Infant wide-field fundus photograph.
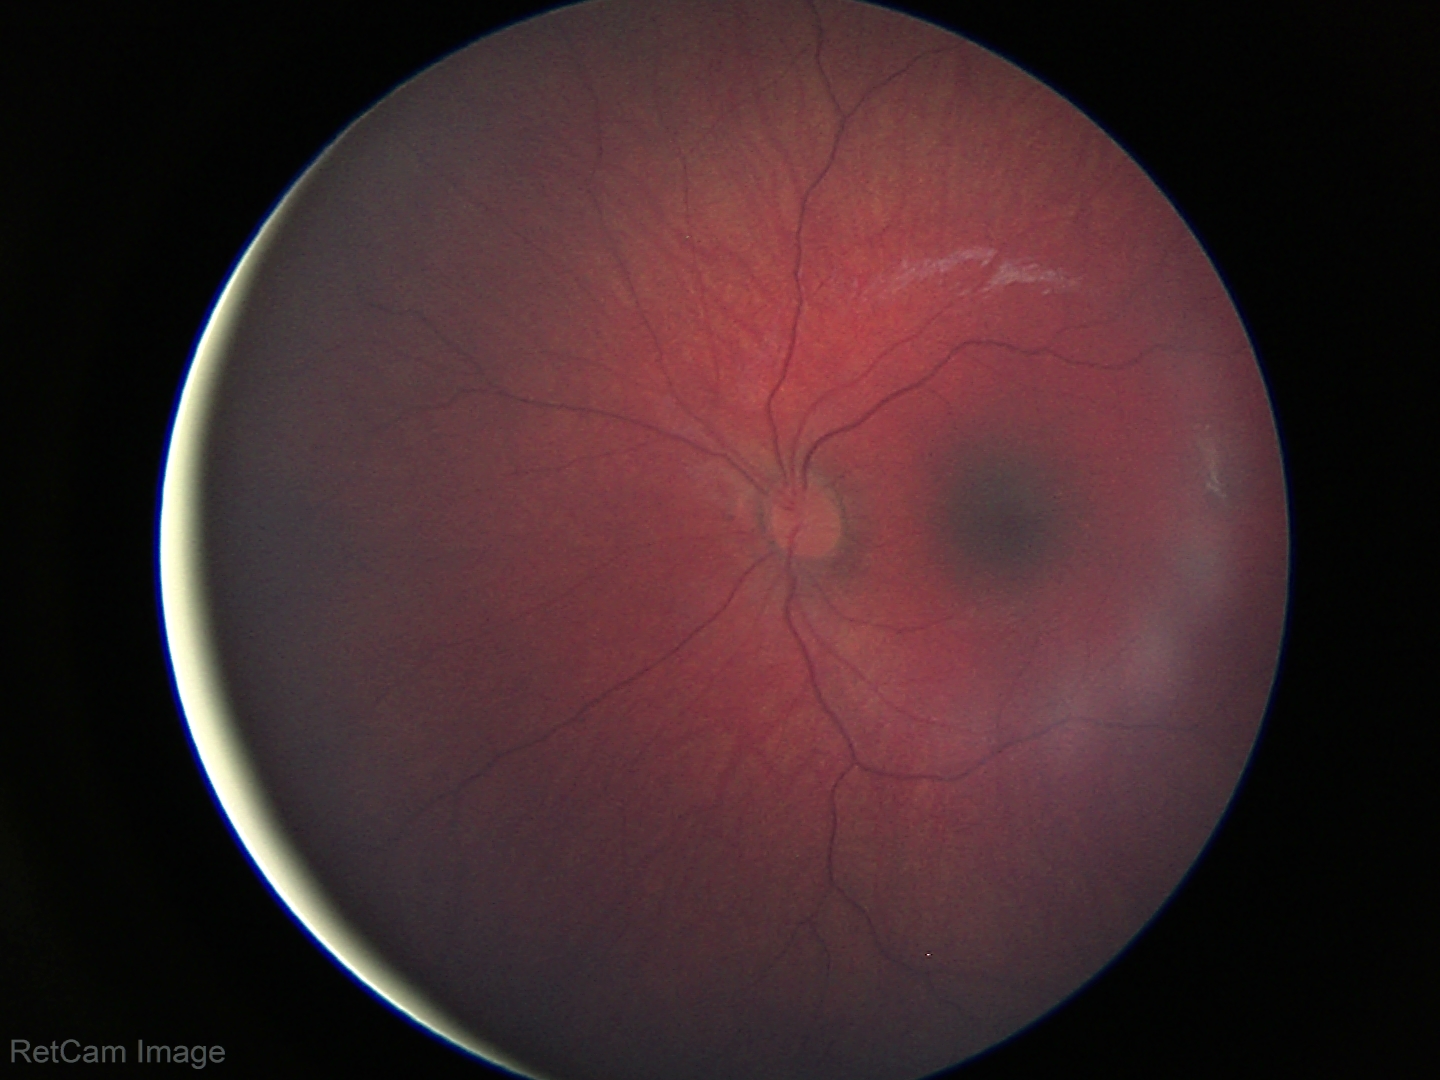 Finding = physiological.